2184x1690px
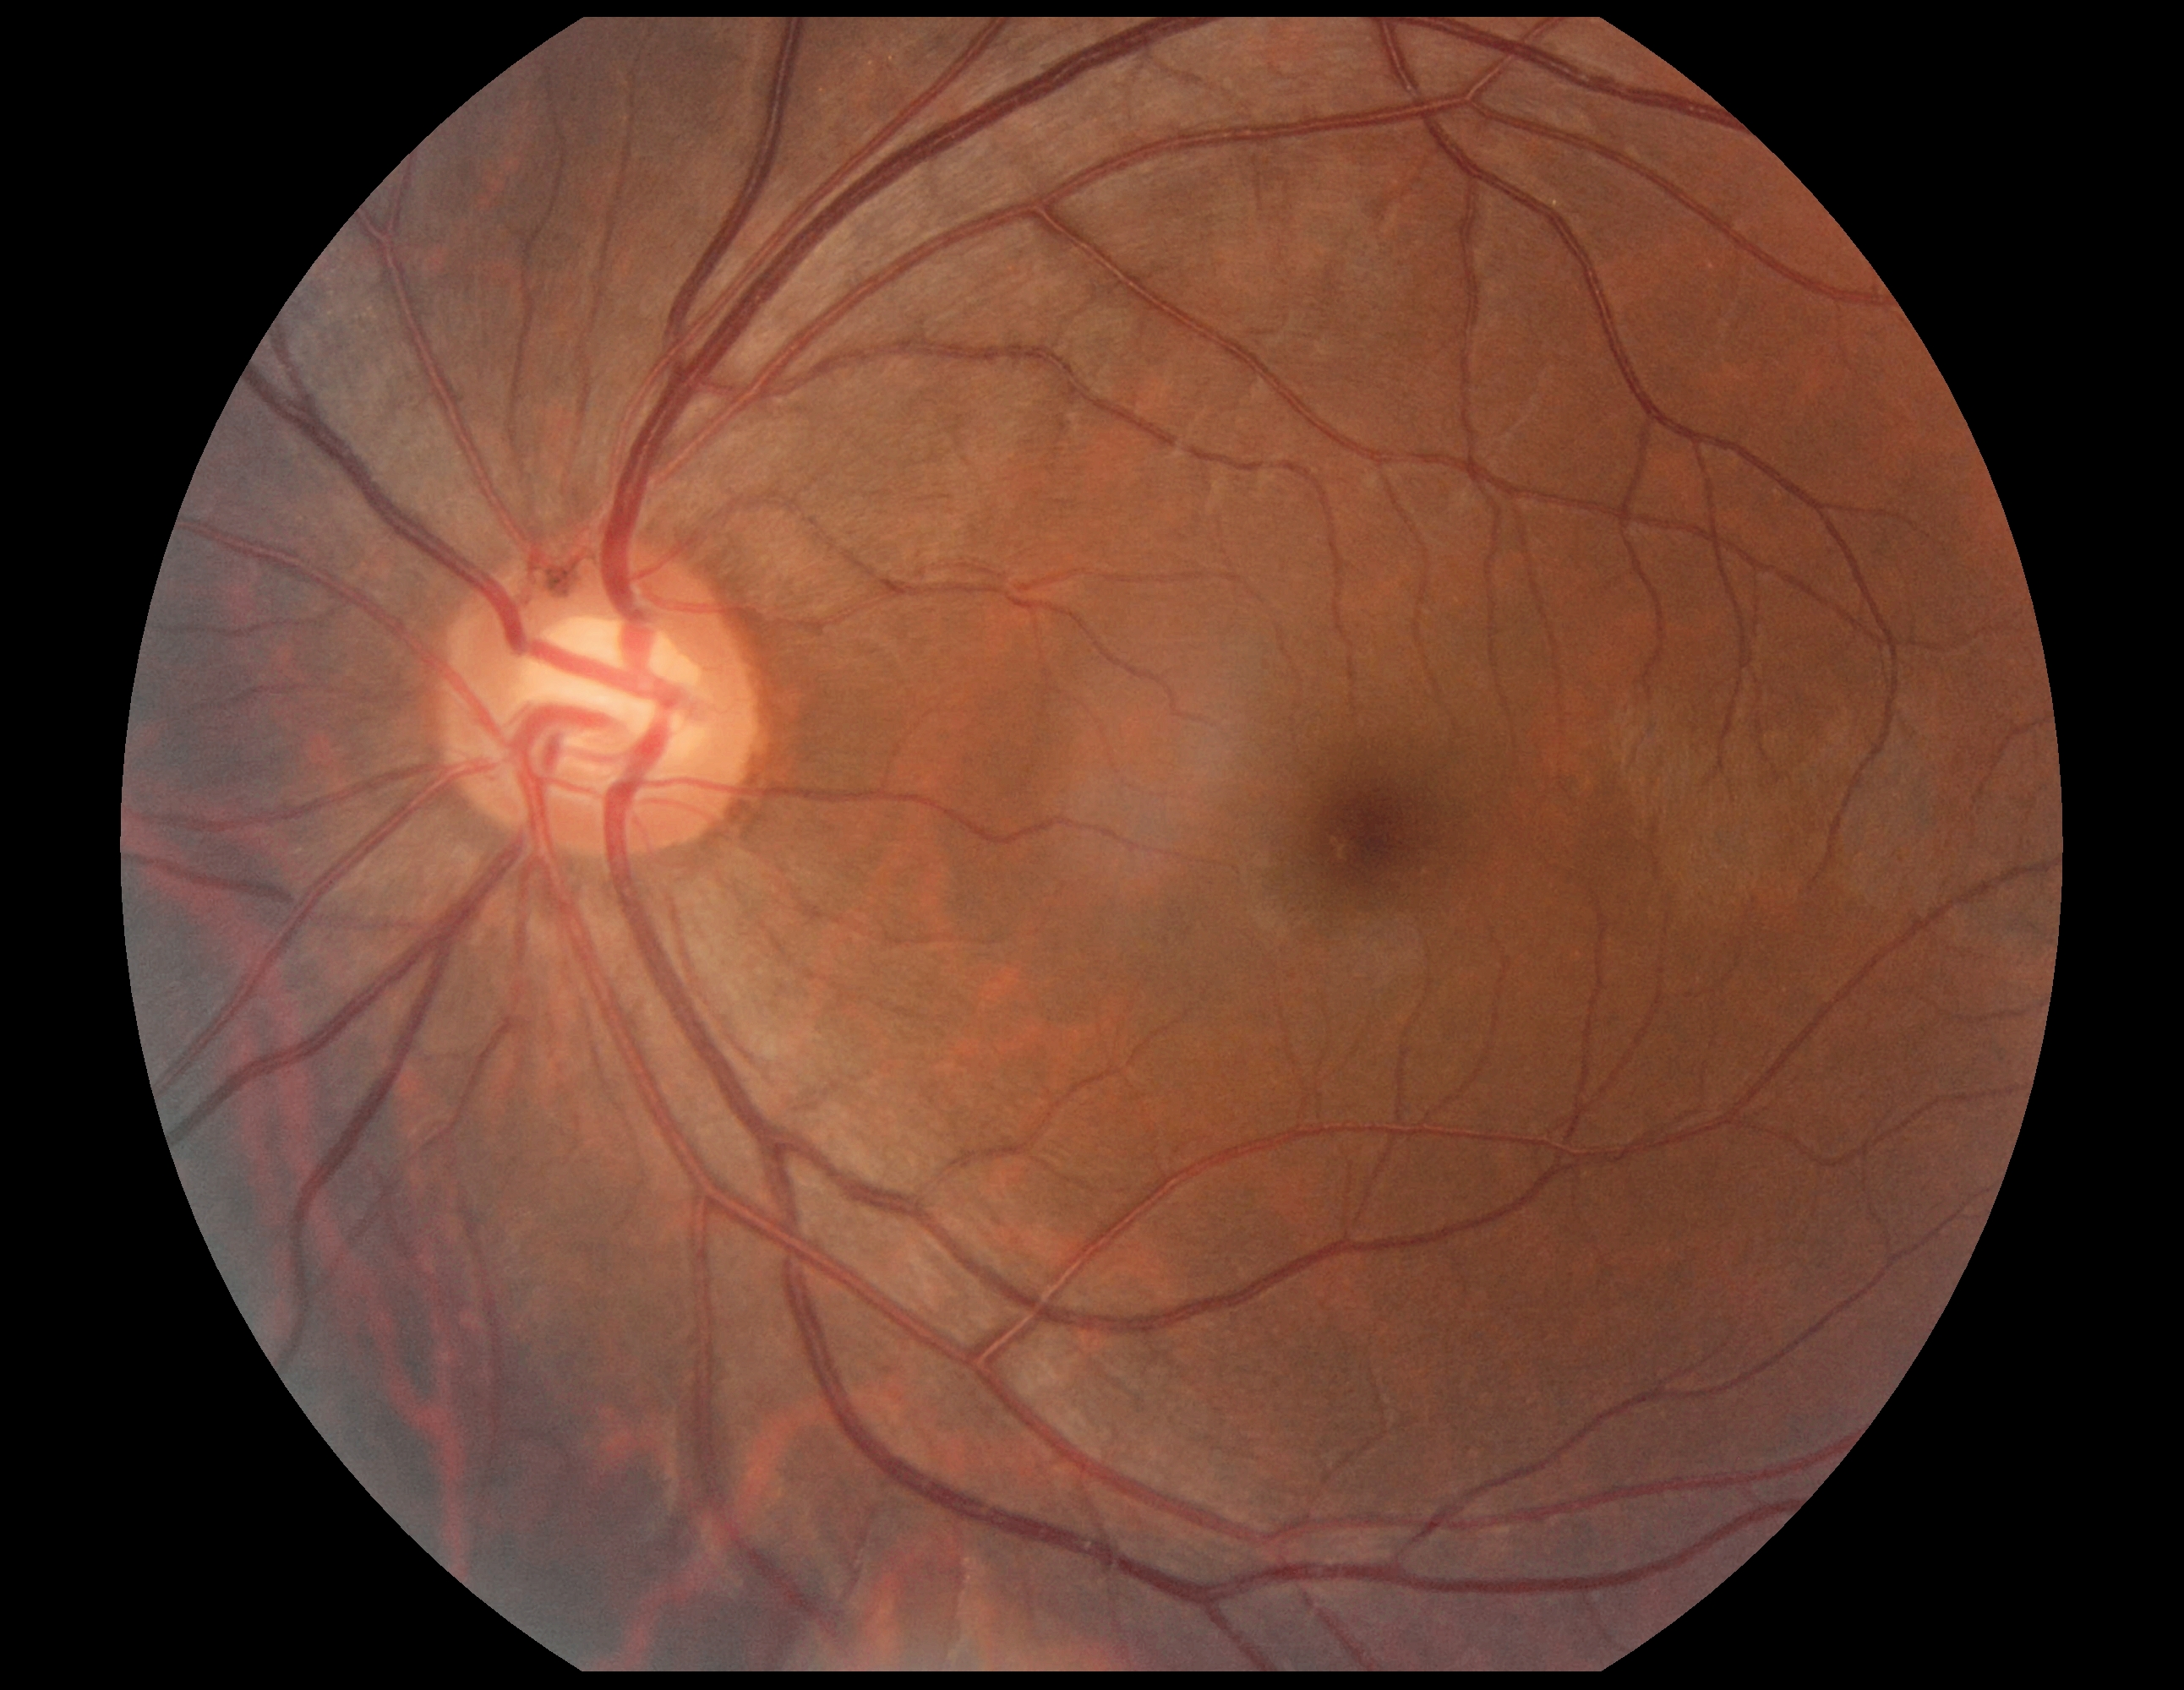

{
  "dr_grade": "no apparent retinopathy (grade 0)"
}